640 x 480 pixels; wide-field fundus photograph from neonatal ROP screening
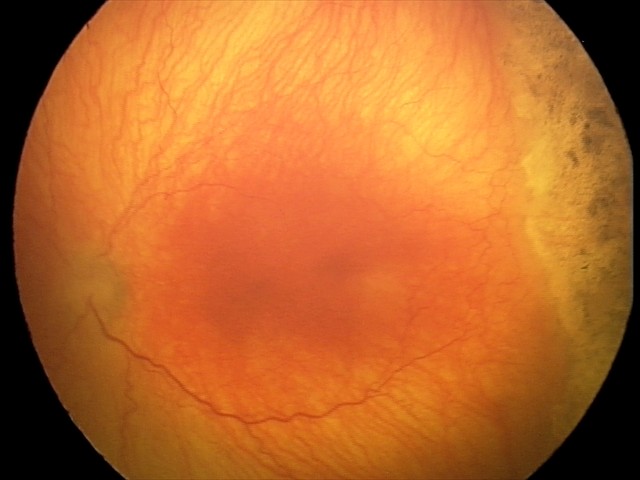

Plus disease was diagnosed. Screening examination consistent with aggressive retinopathy of prematurity.